NIDEK AFC-230
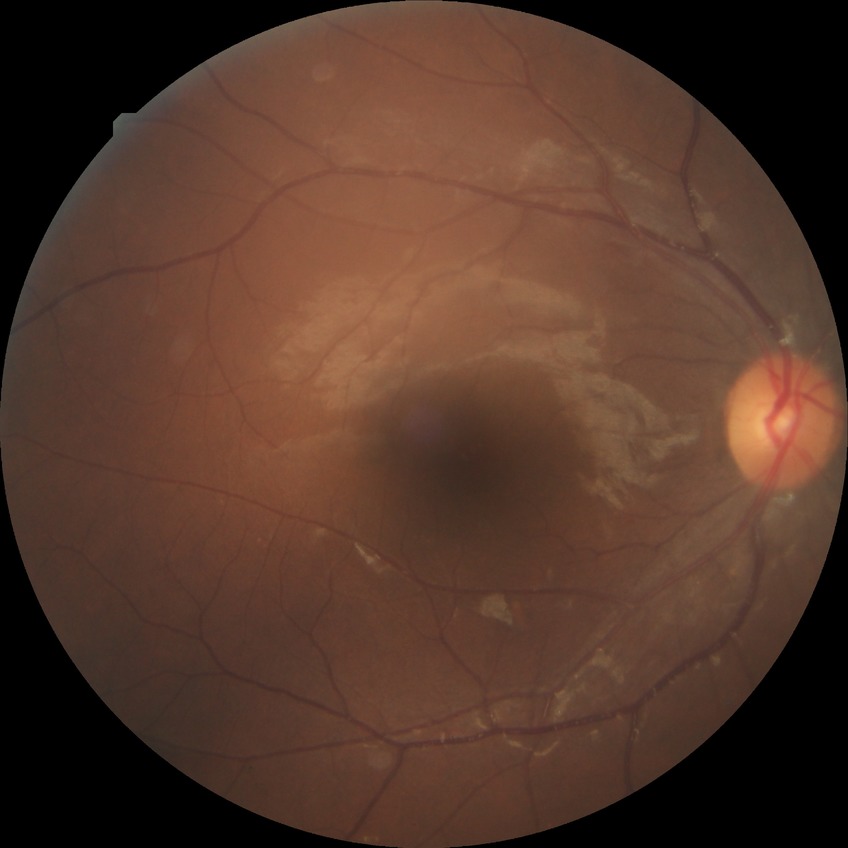
diabetic retinopathy severity: simple diabetic retinopathy.